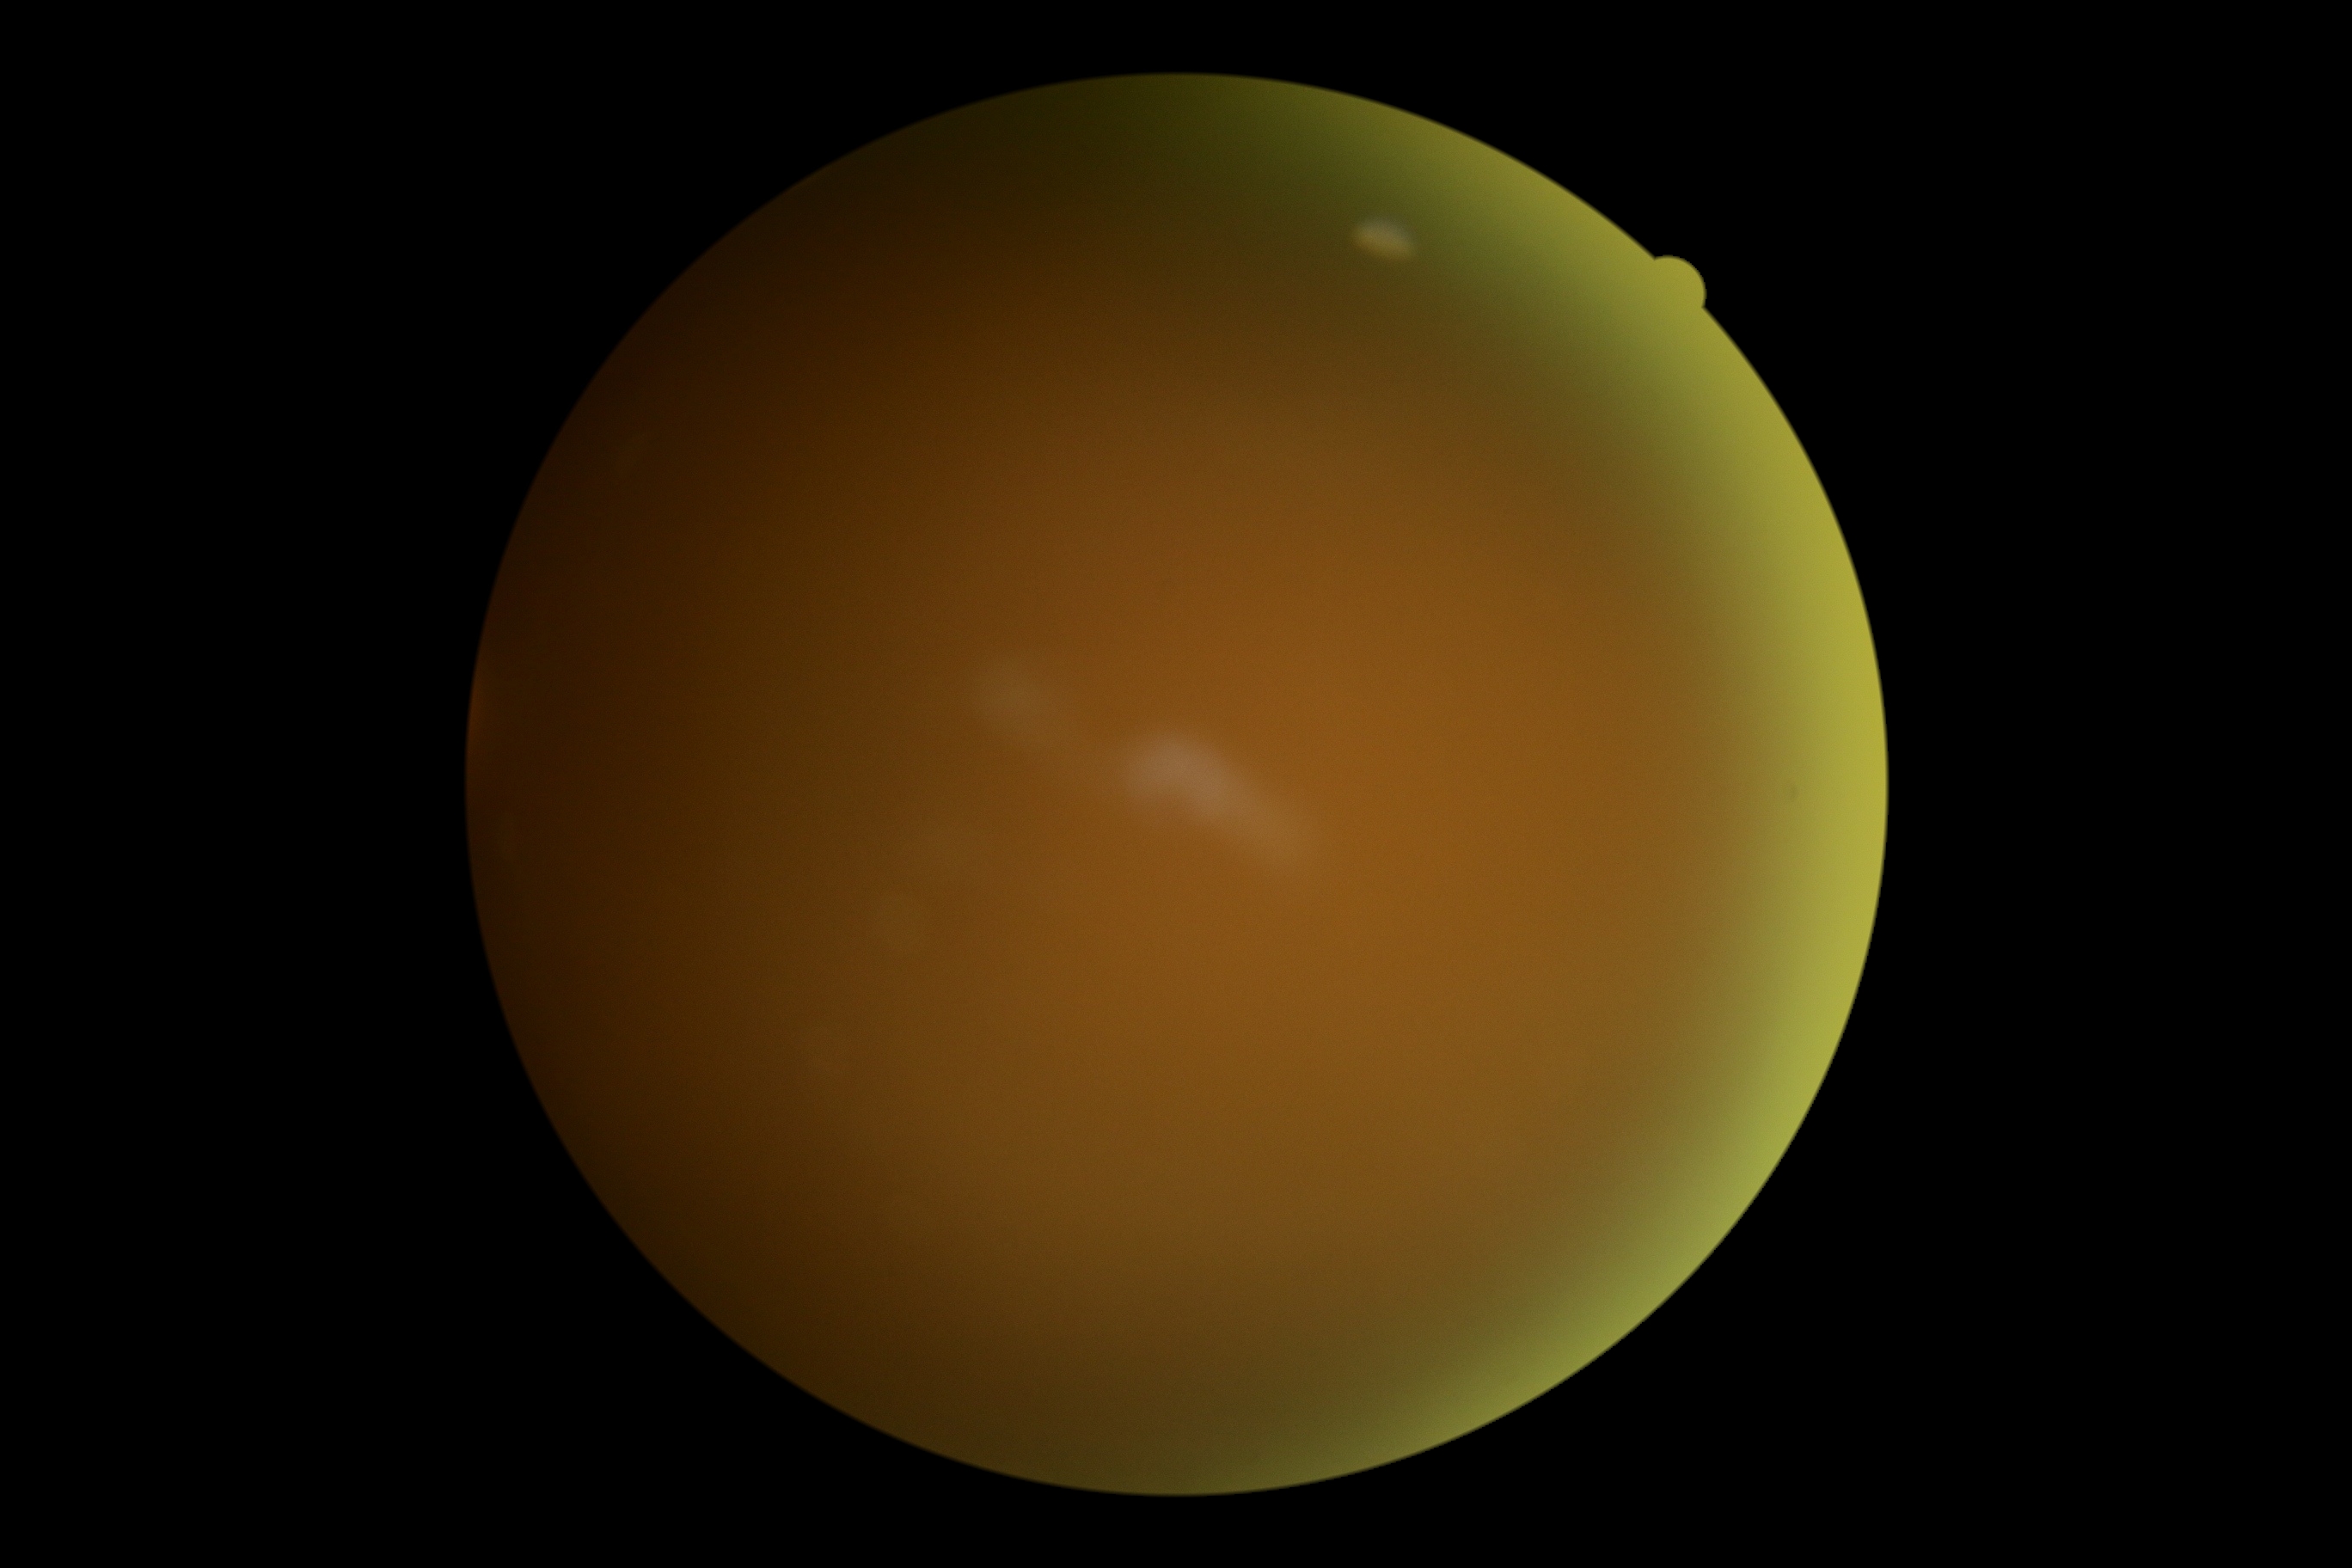
DR severity is ungradable due to poor image quality. Image quality is insufficient for diabetic retinopathy assessment.